1240x1240; wide-field fundus photograph from neonatal ROP screening — 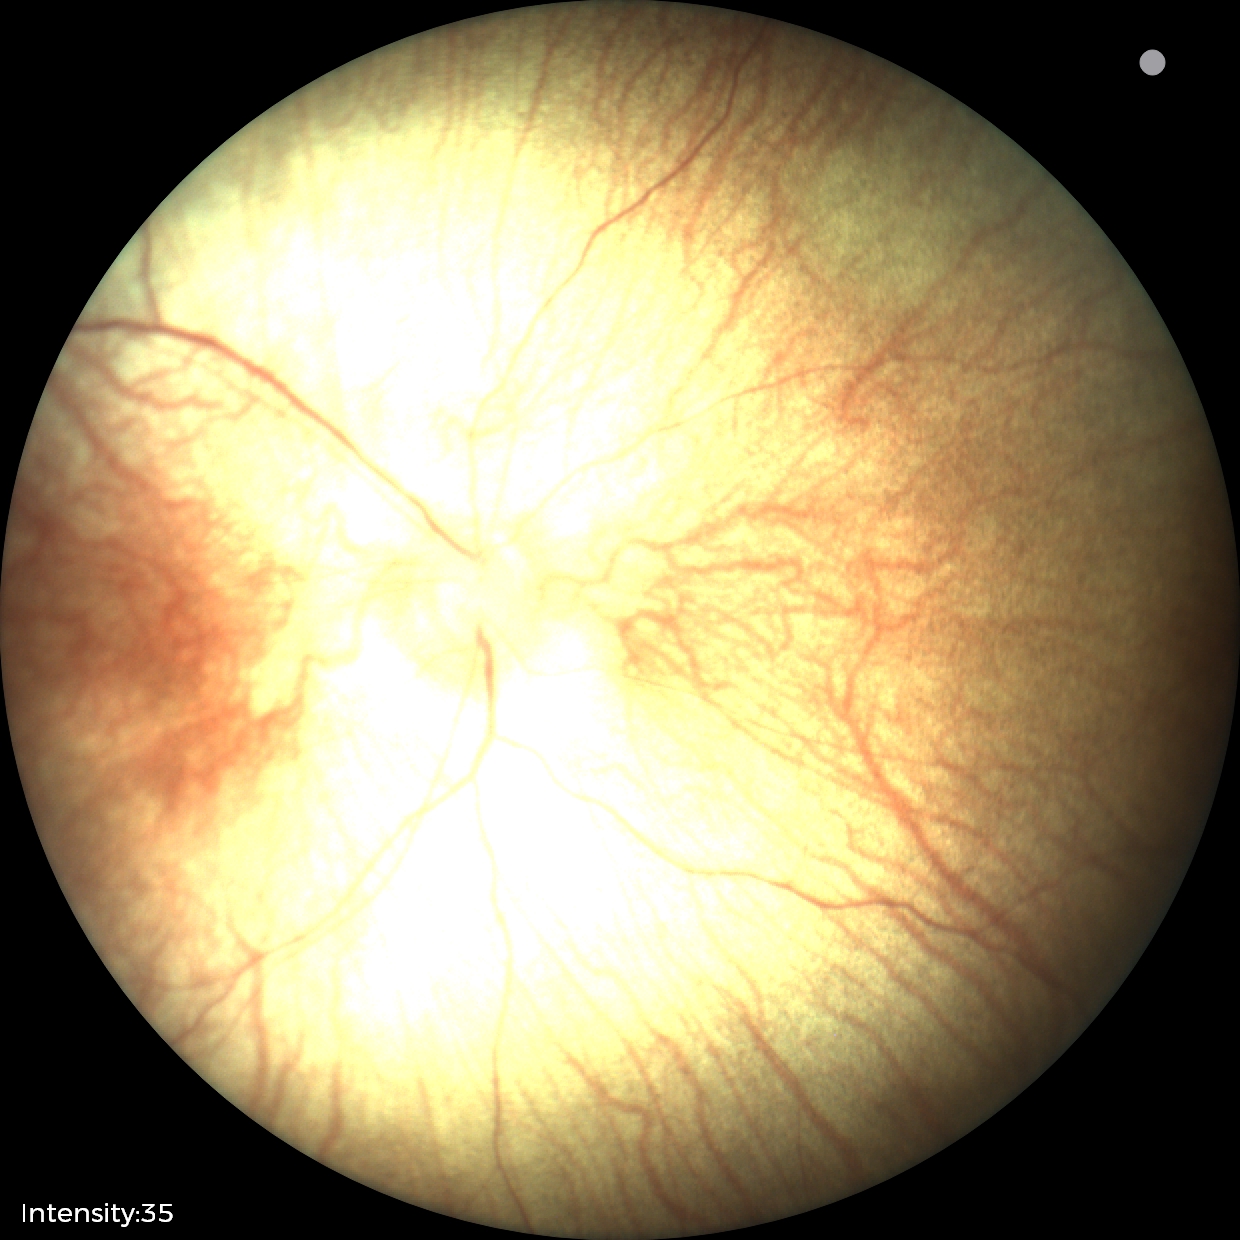

Impression: no pathology identified.